1932x1916px. 45° field of view — 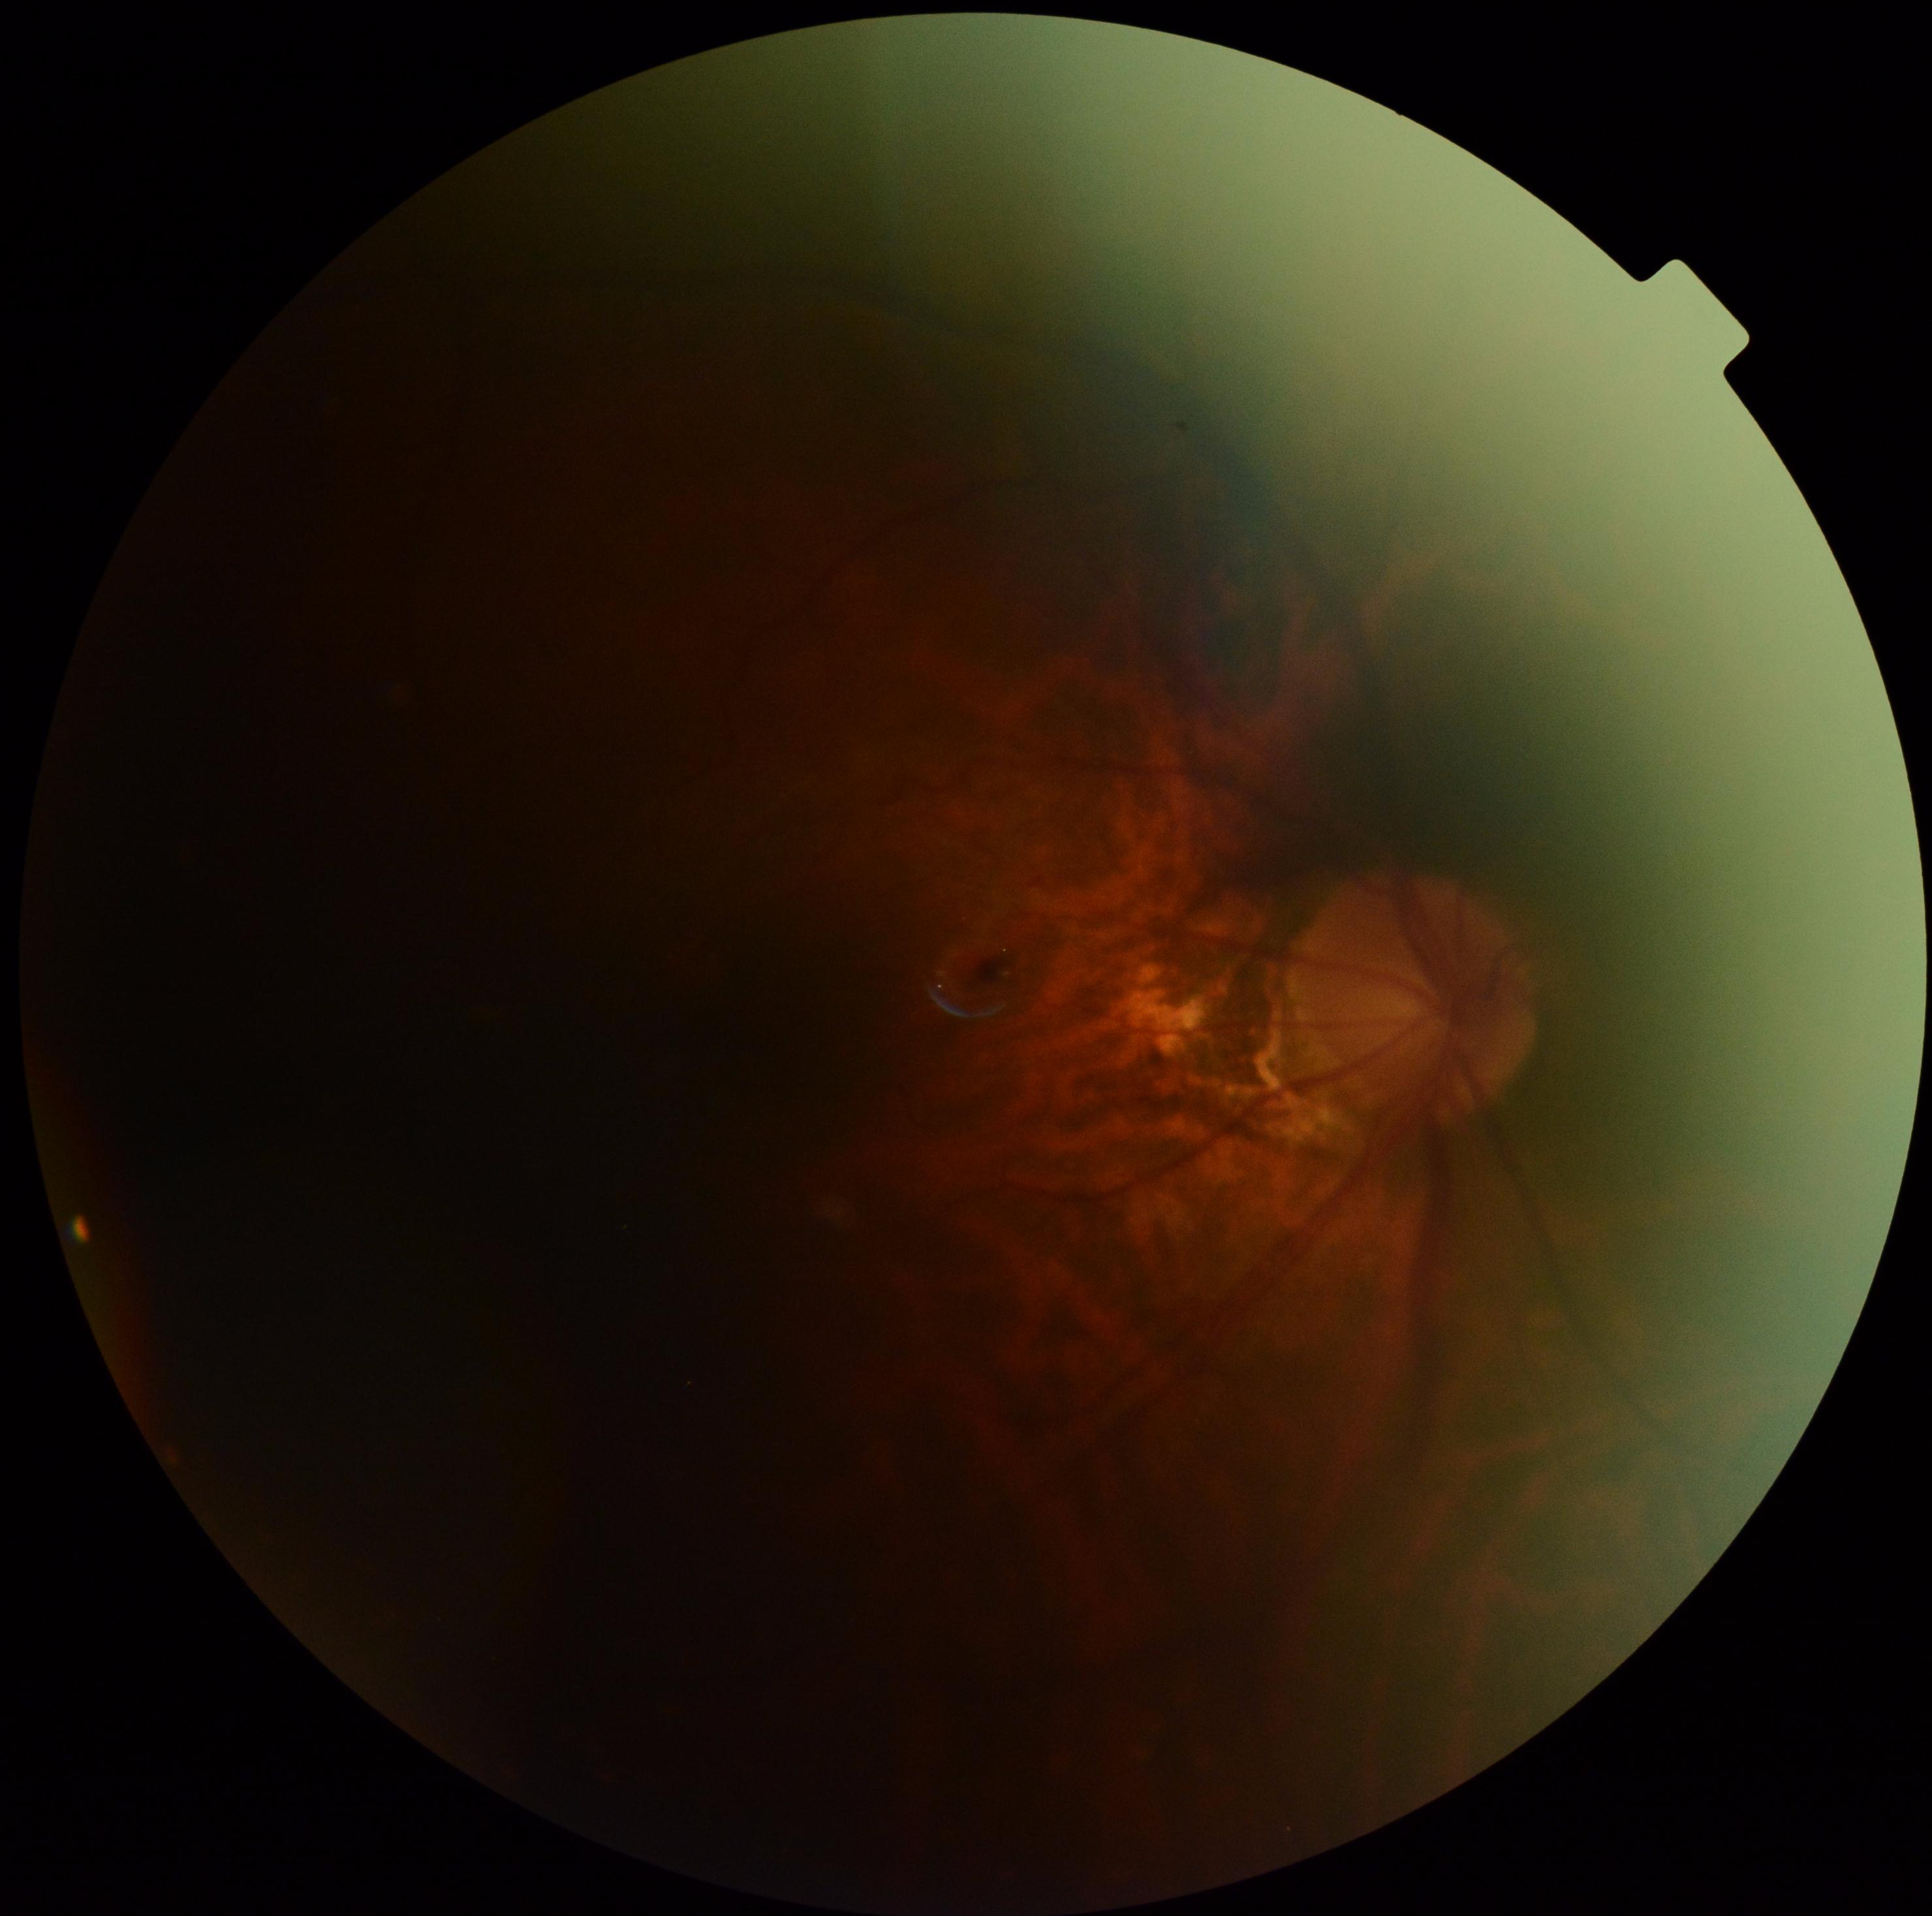
DR severity: ungradable.